Image size 848x848: 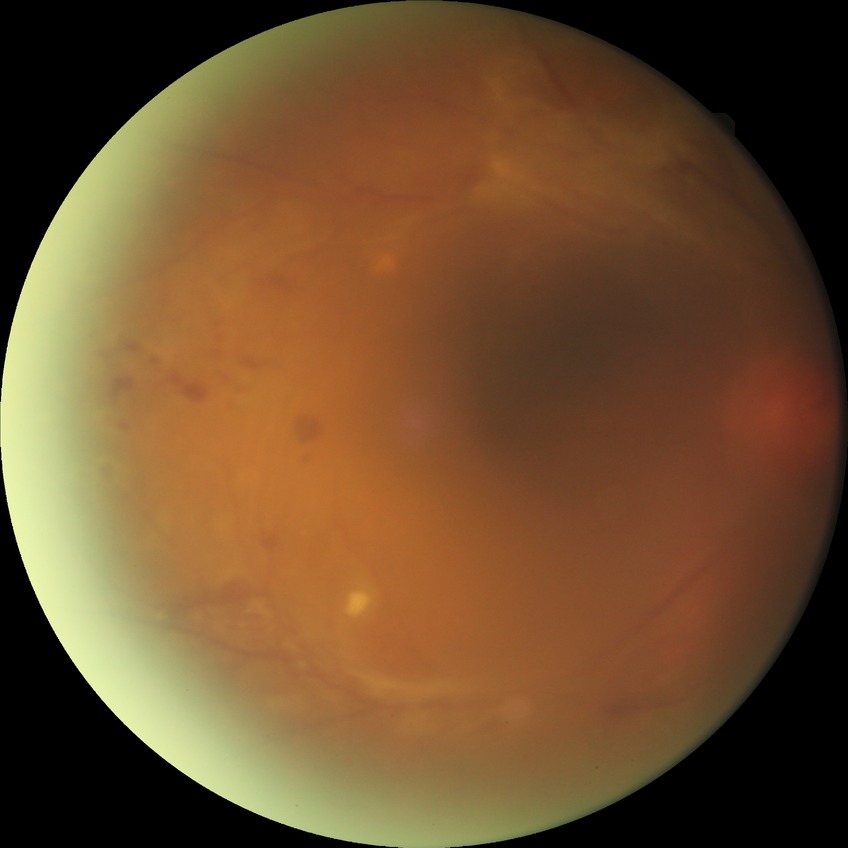

DR severity is PDR.